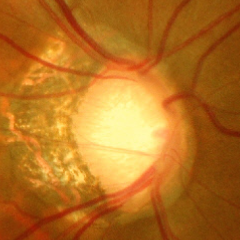

Findings consistent with advanced-stage glaucoma.